2352 x 1568 pixels, 45-degree field of view, color fundus image.
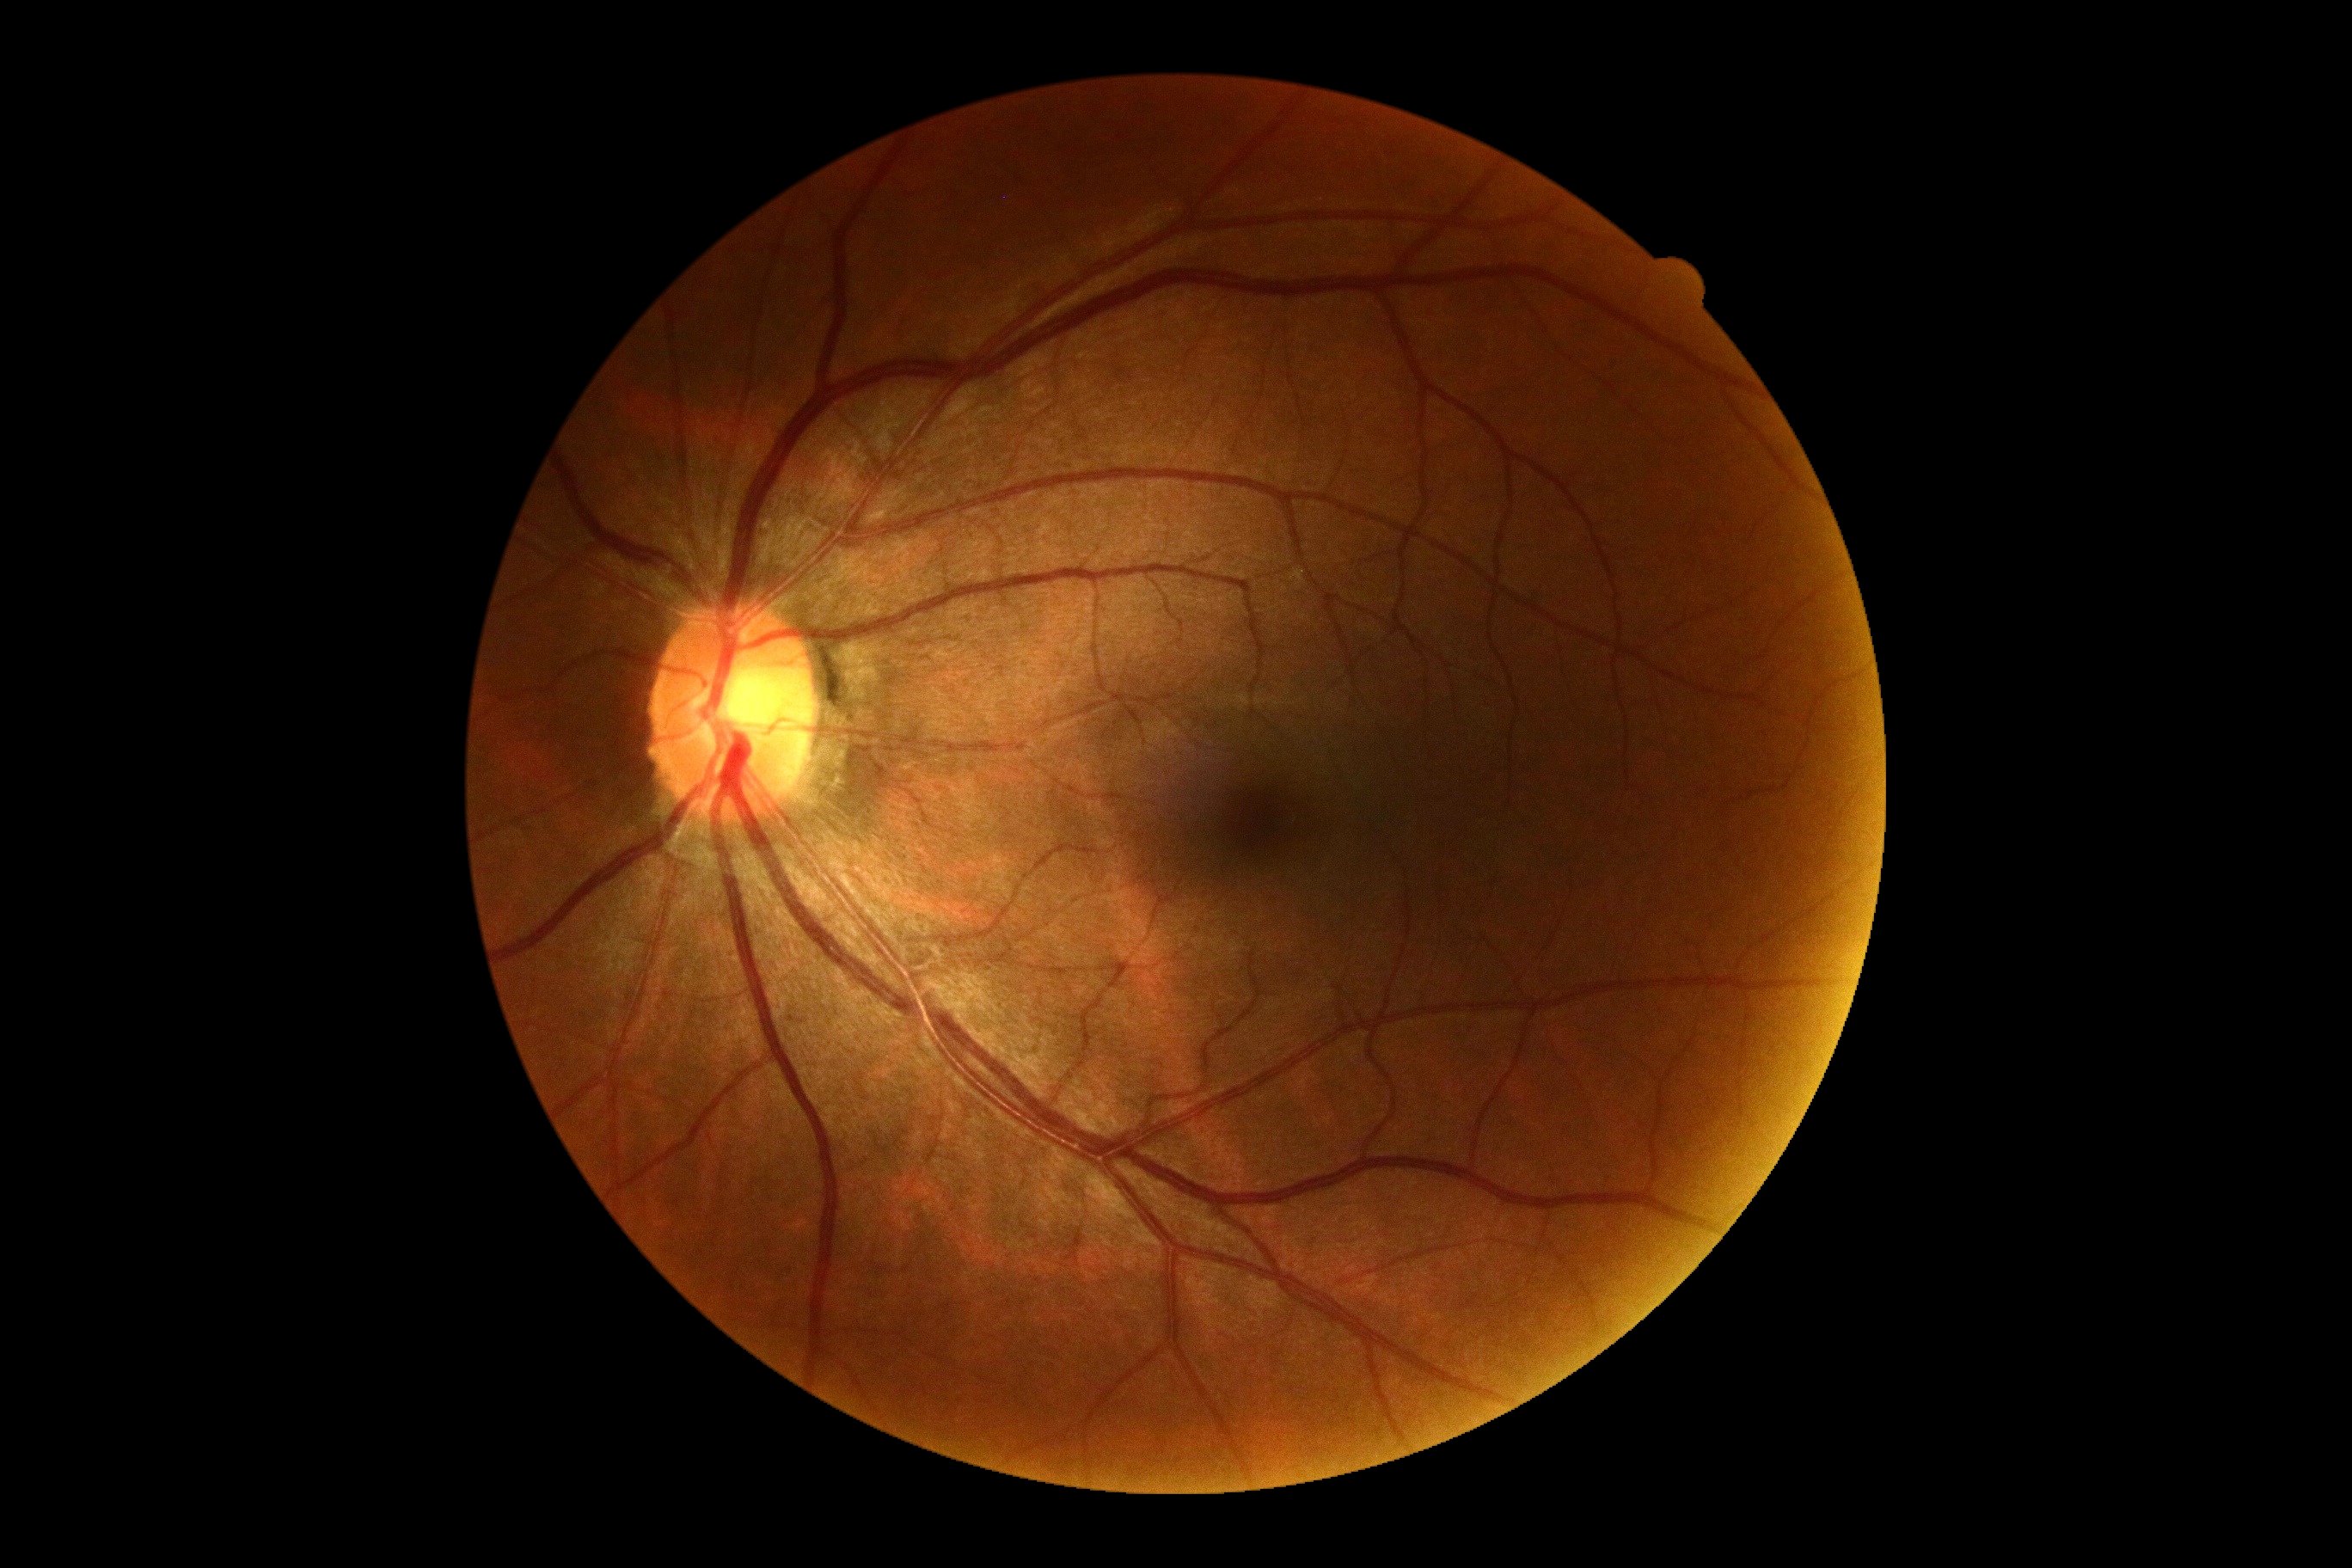 No apparent diabetic retinopathy. DR is no apparent retinopathy (grade 0).